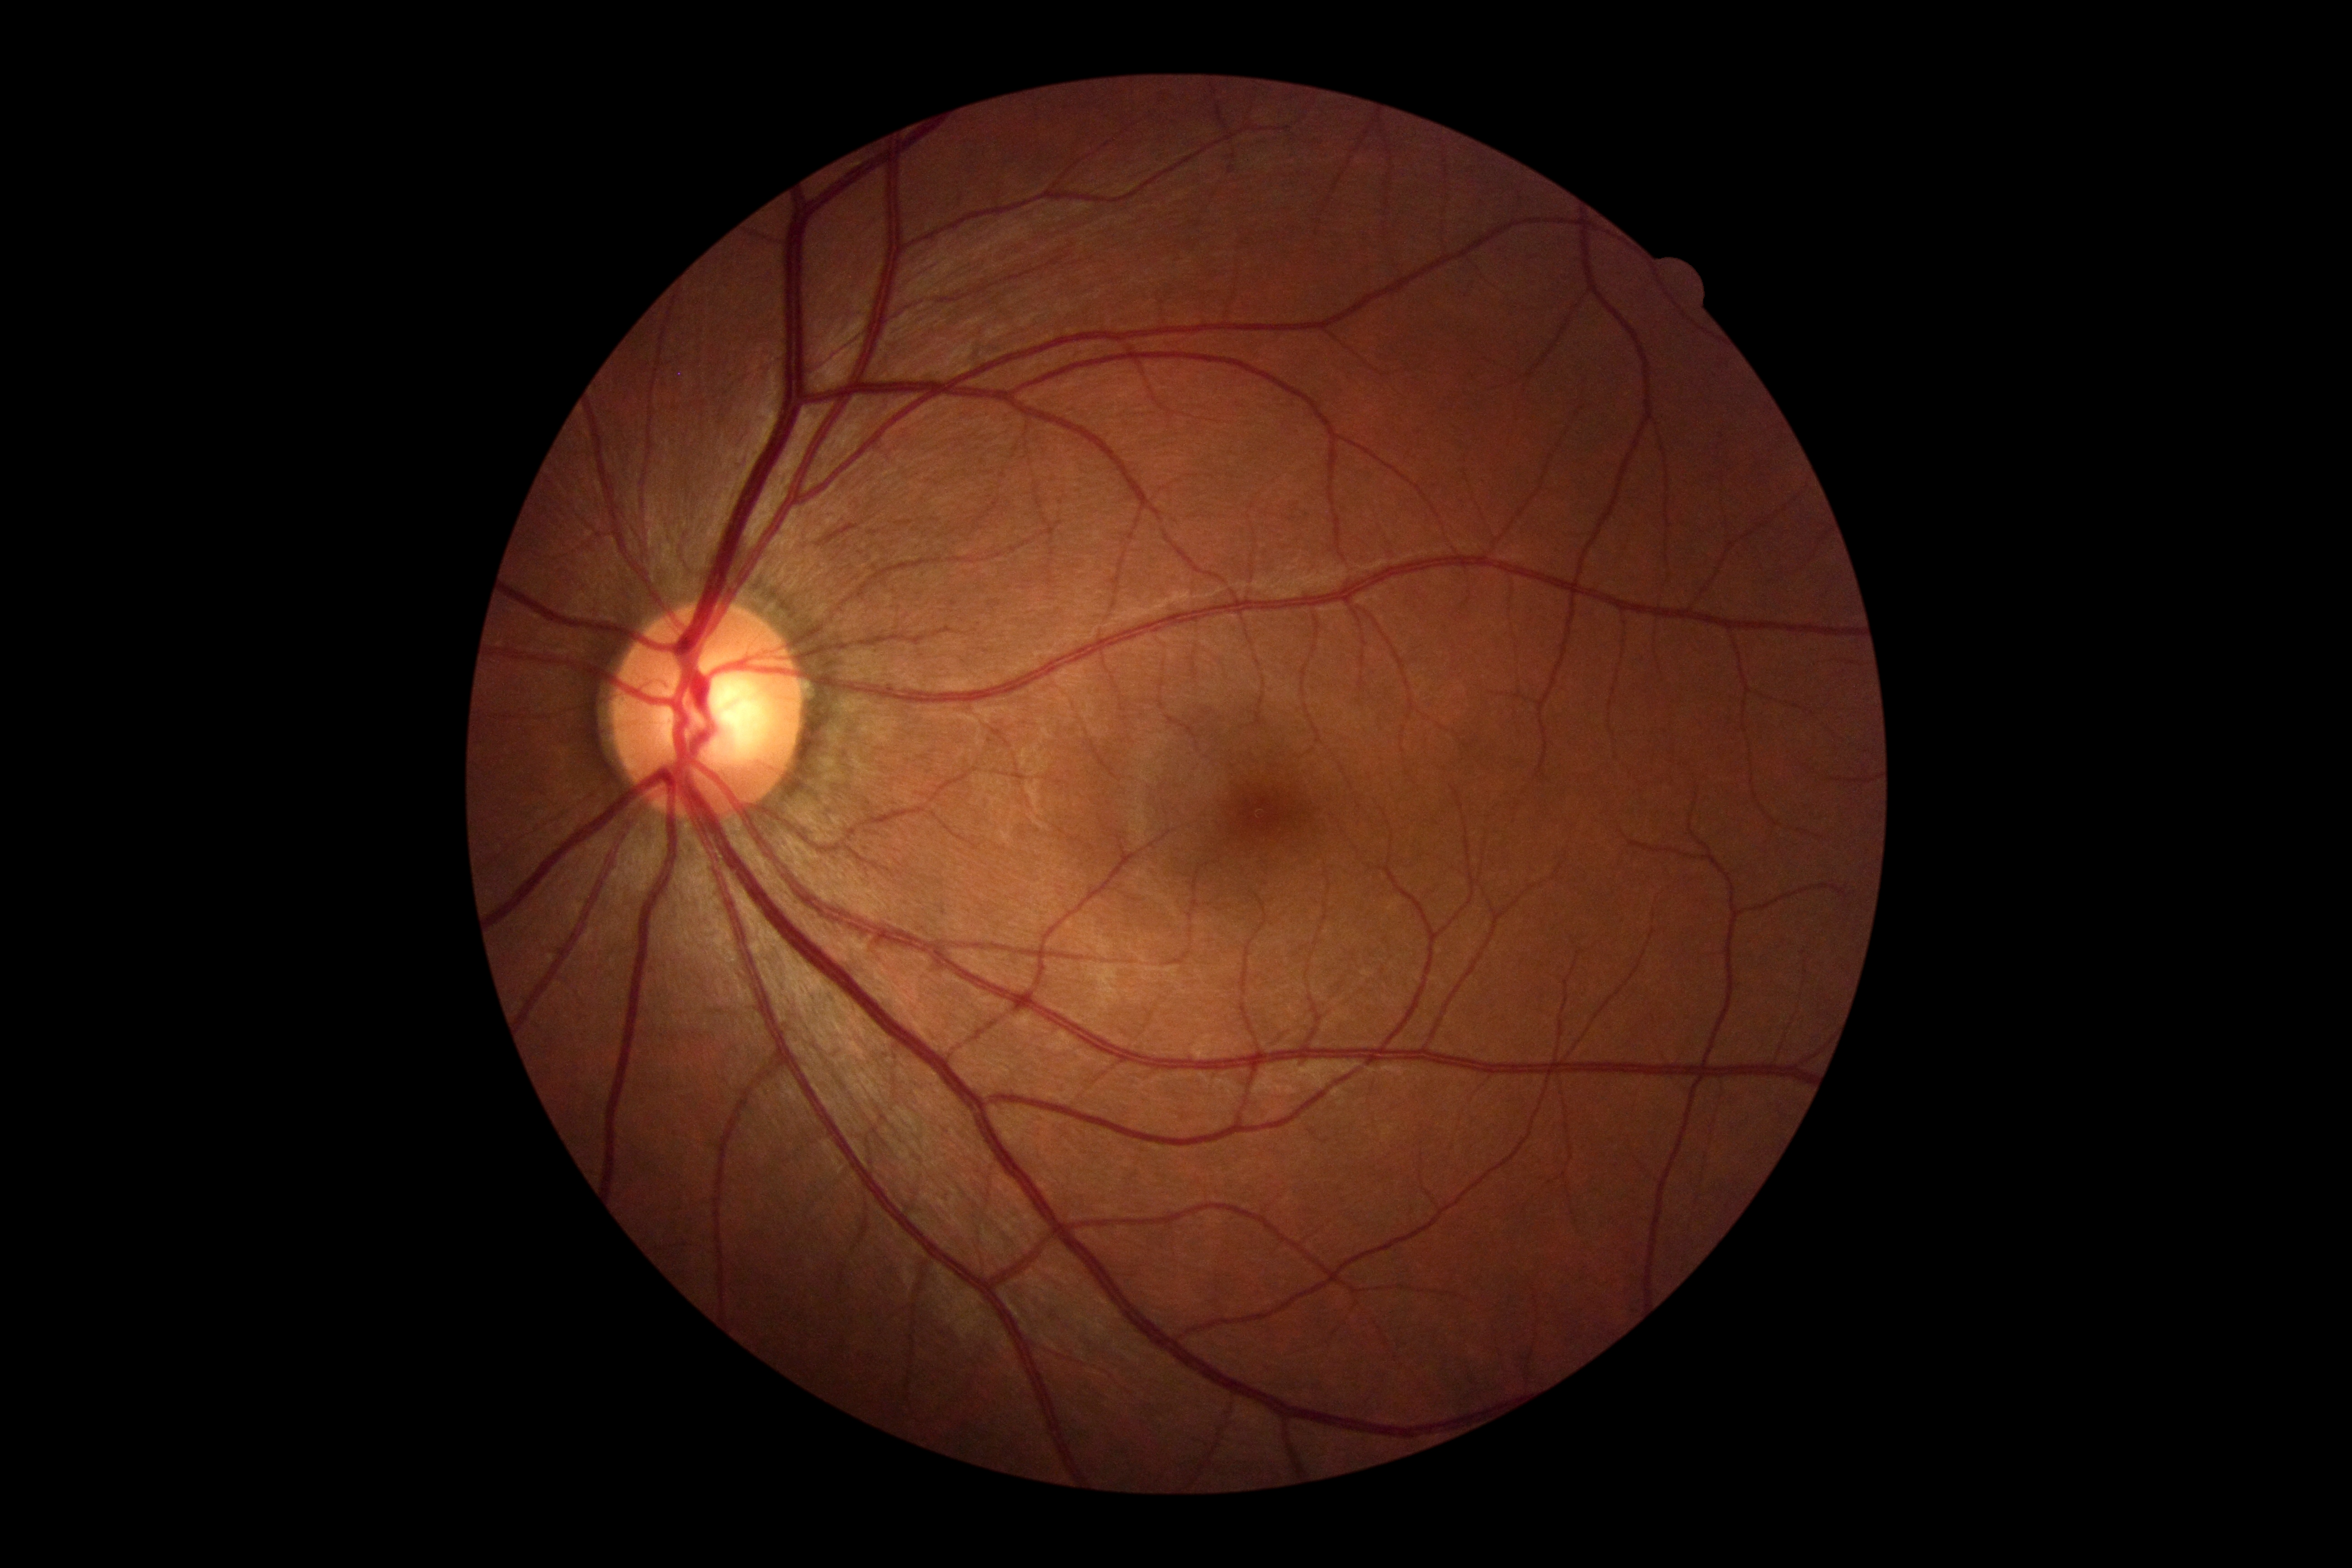

DR: 0.